45° field of view: 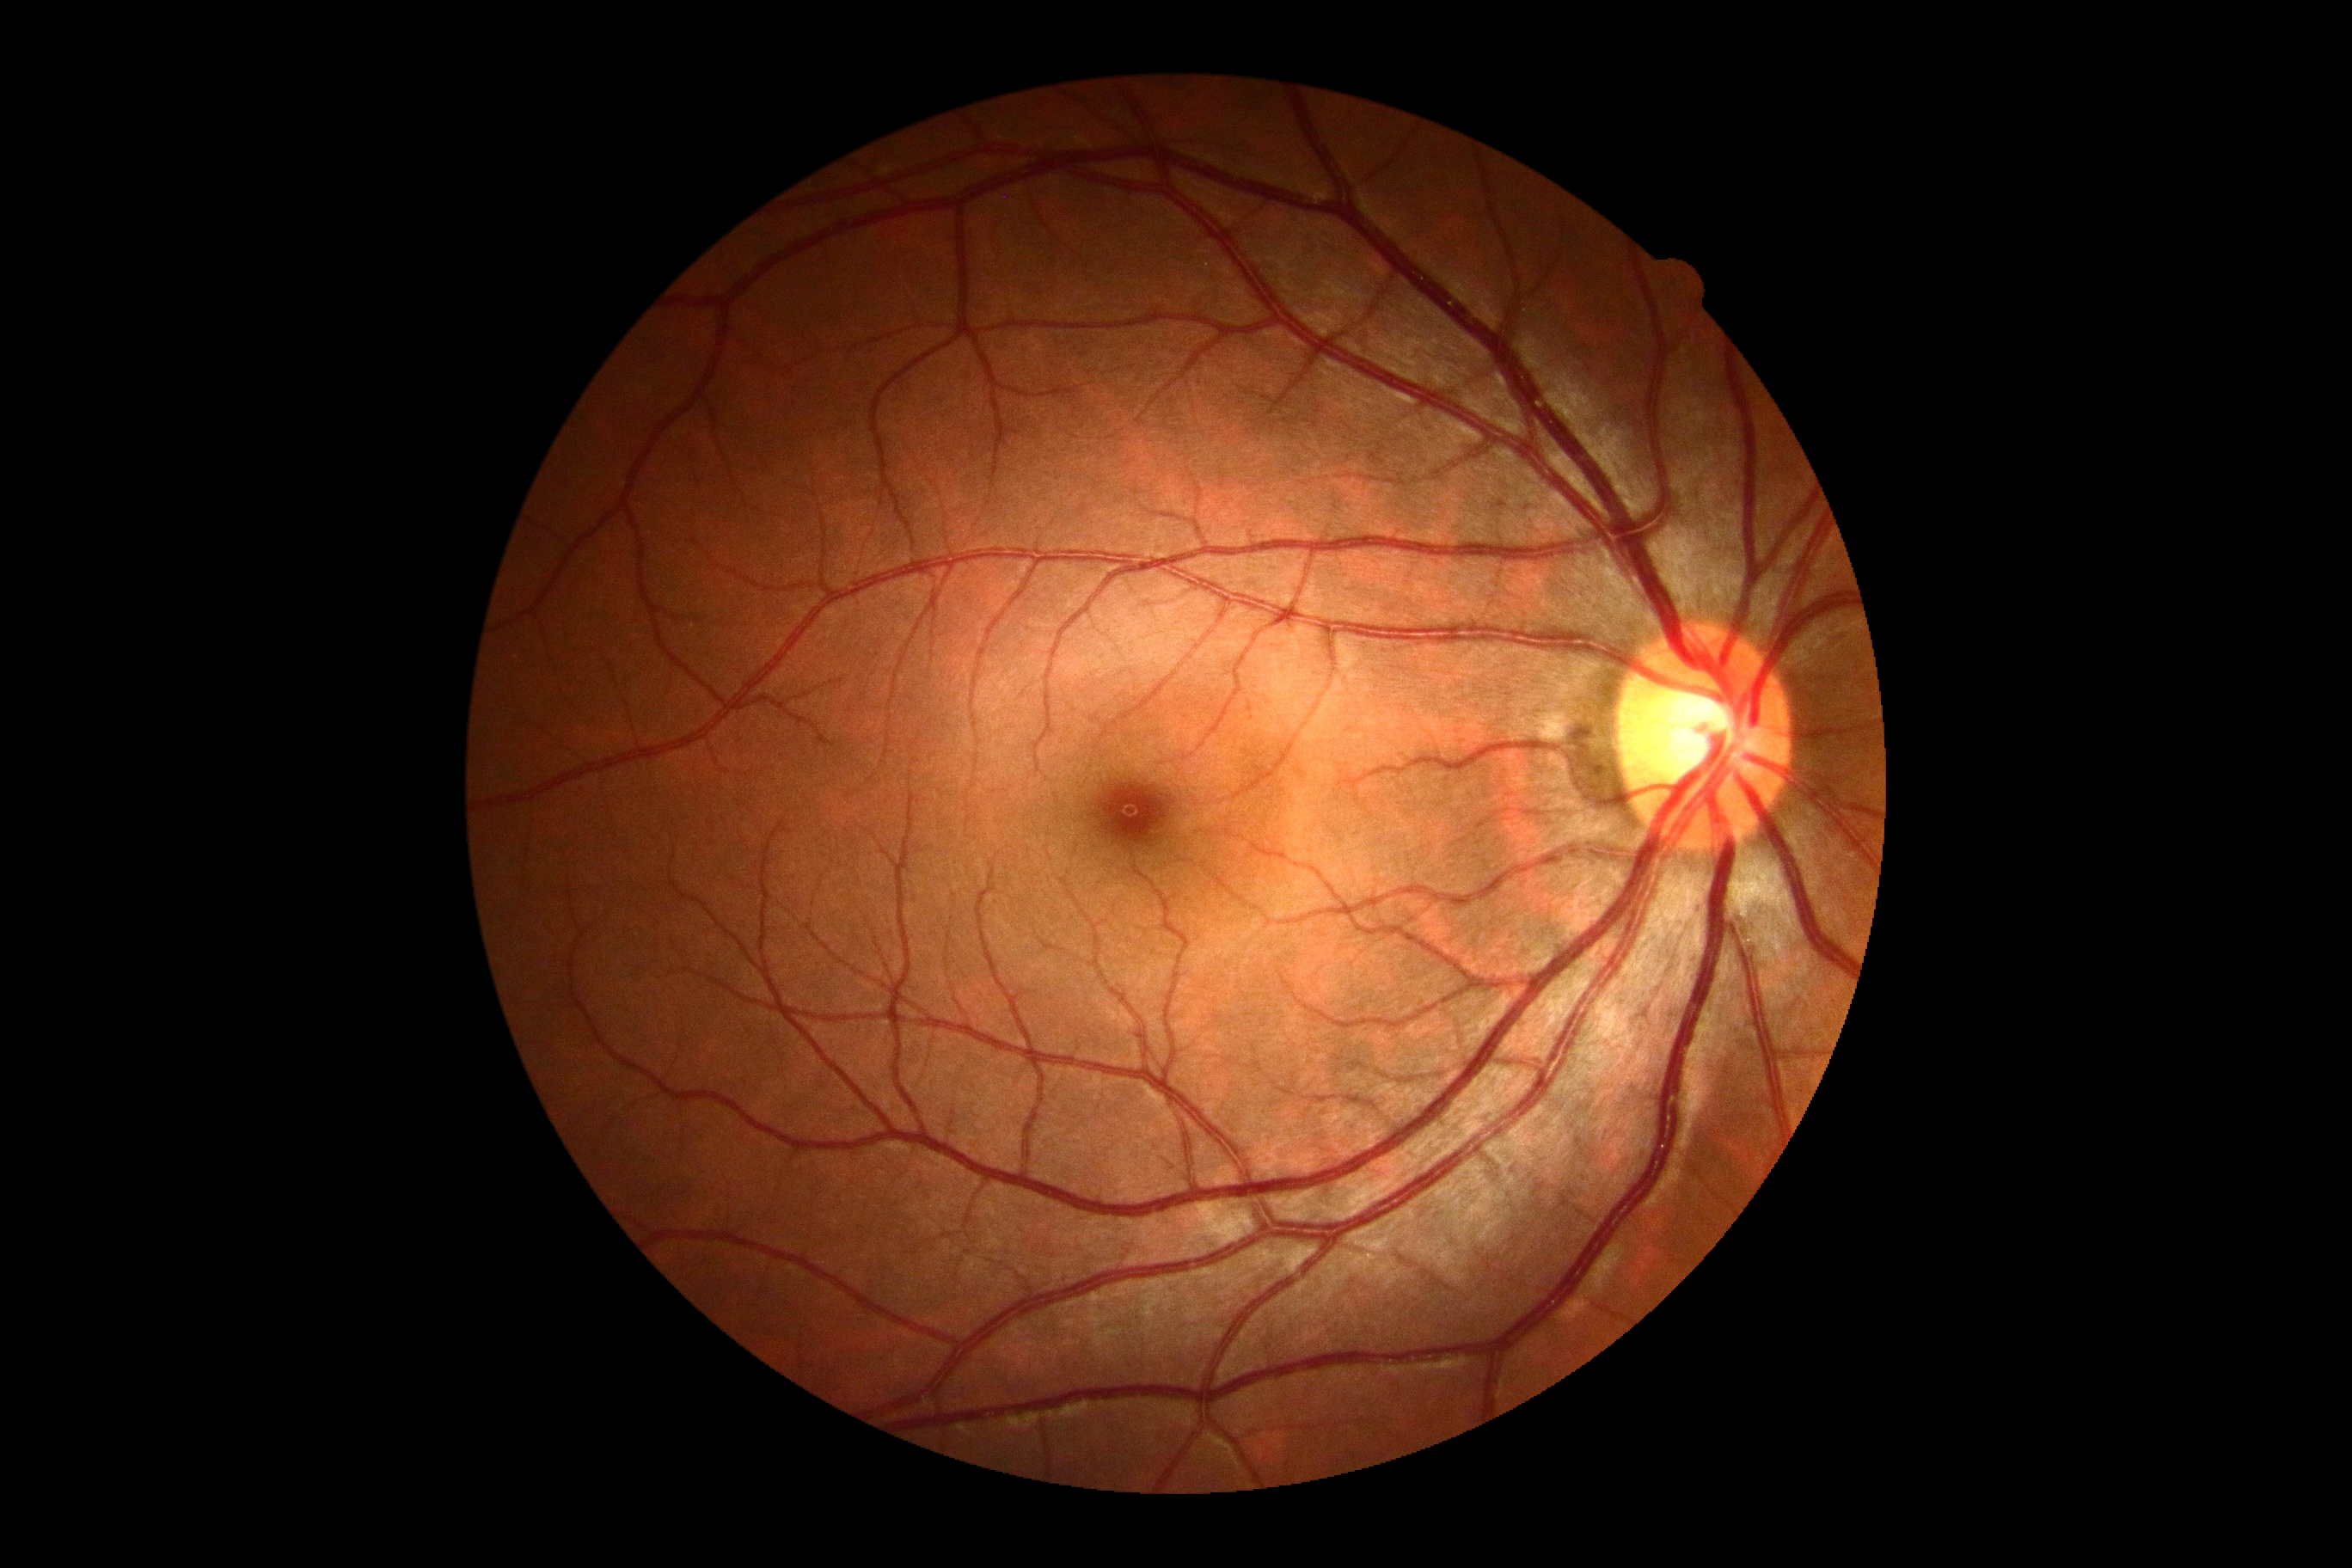

Findings:
* retinopathy — 0/4